Retinal fundus photograph · Davis DR grading · 848x848
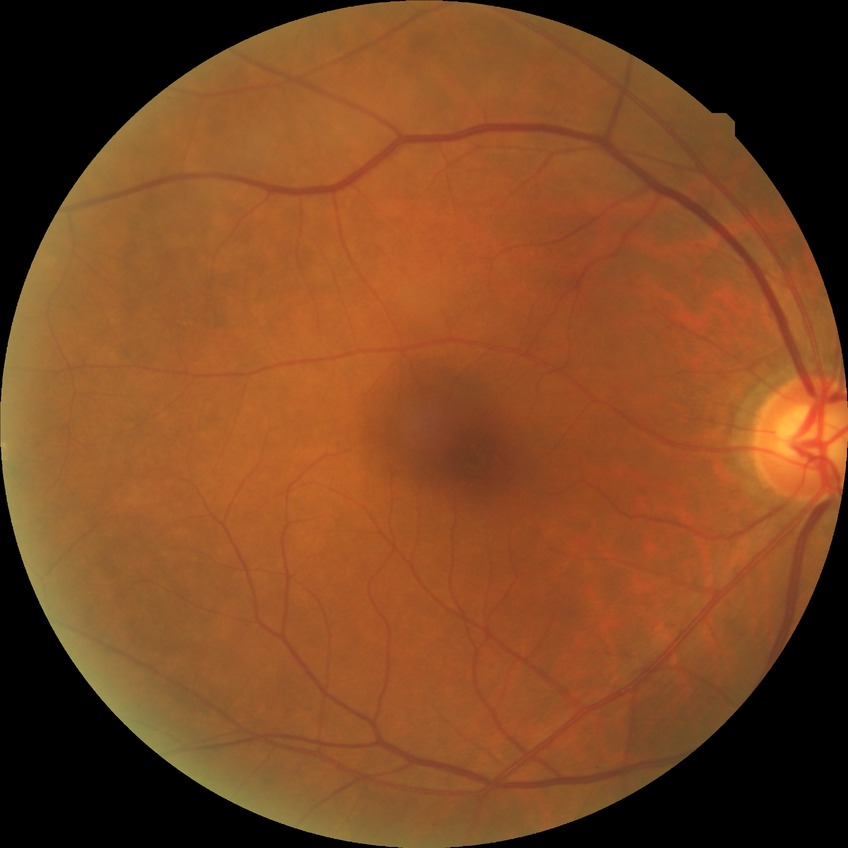   davis_grade: no diabetic retinopathy (NDR)